1440 by 1080 pixels · captured with the Natus RetCam Envision (130° field of view) · wide-field contact fundus photograph of an infant:
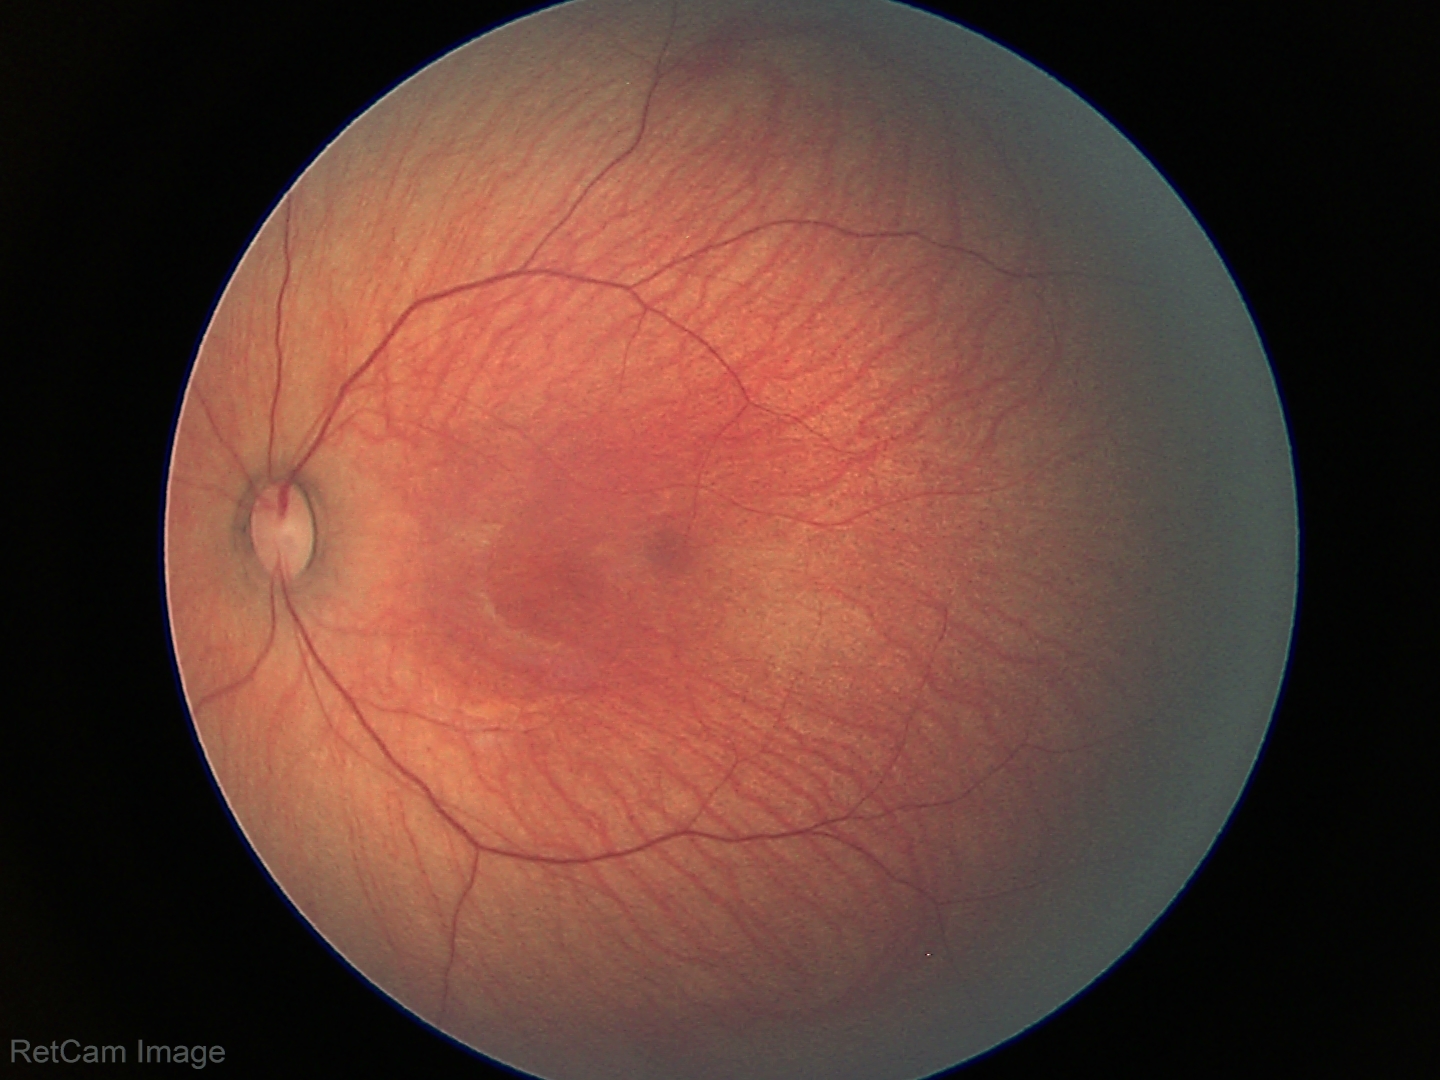
Screening examination with no abnormal retinal findings.